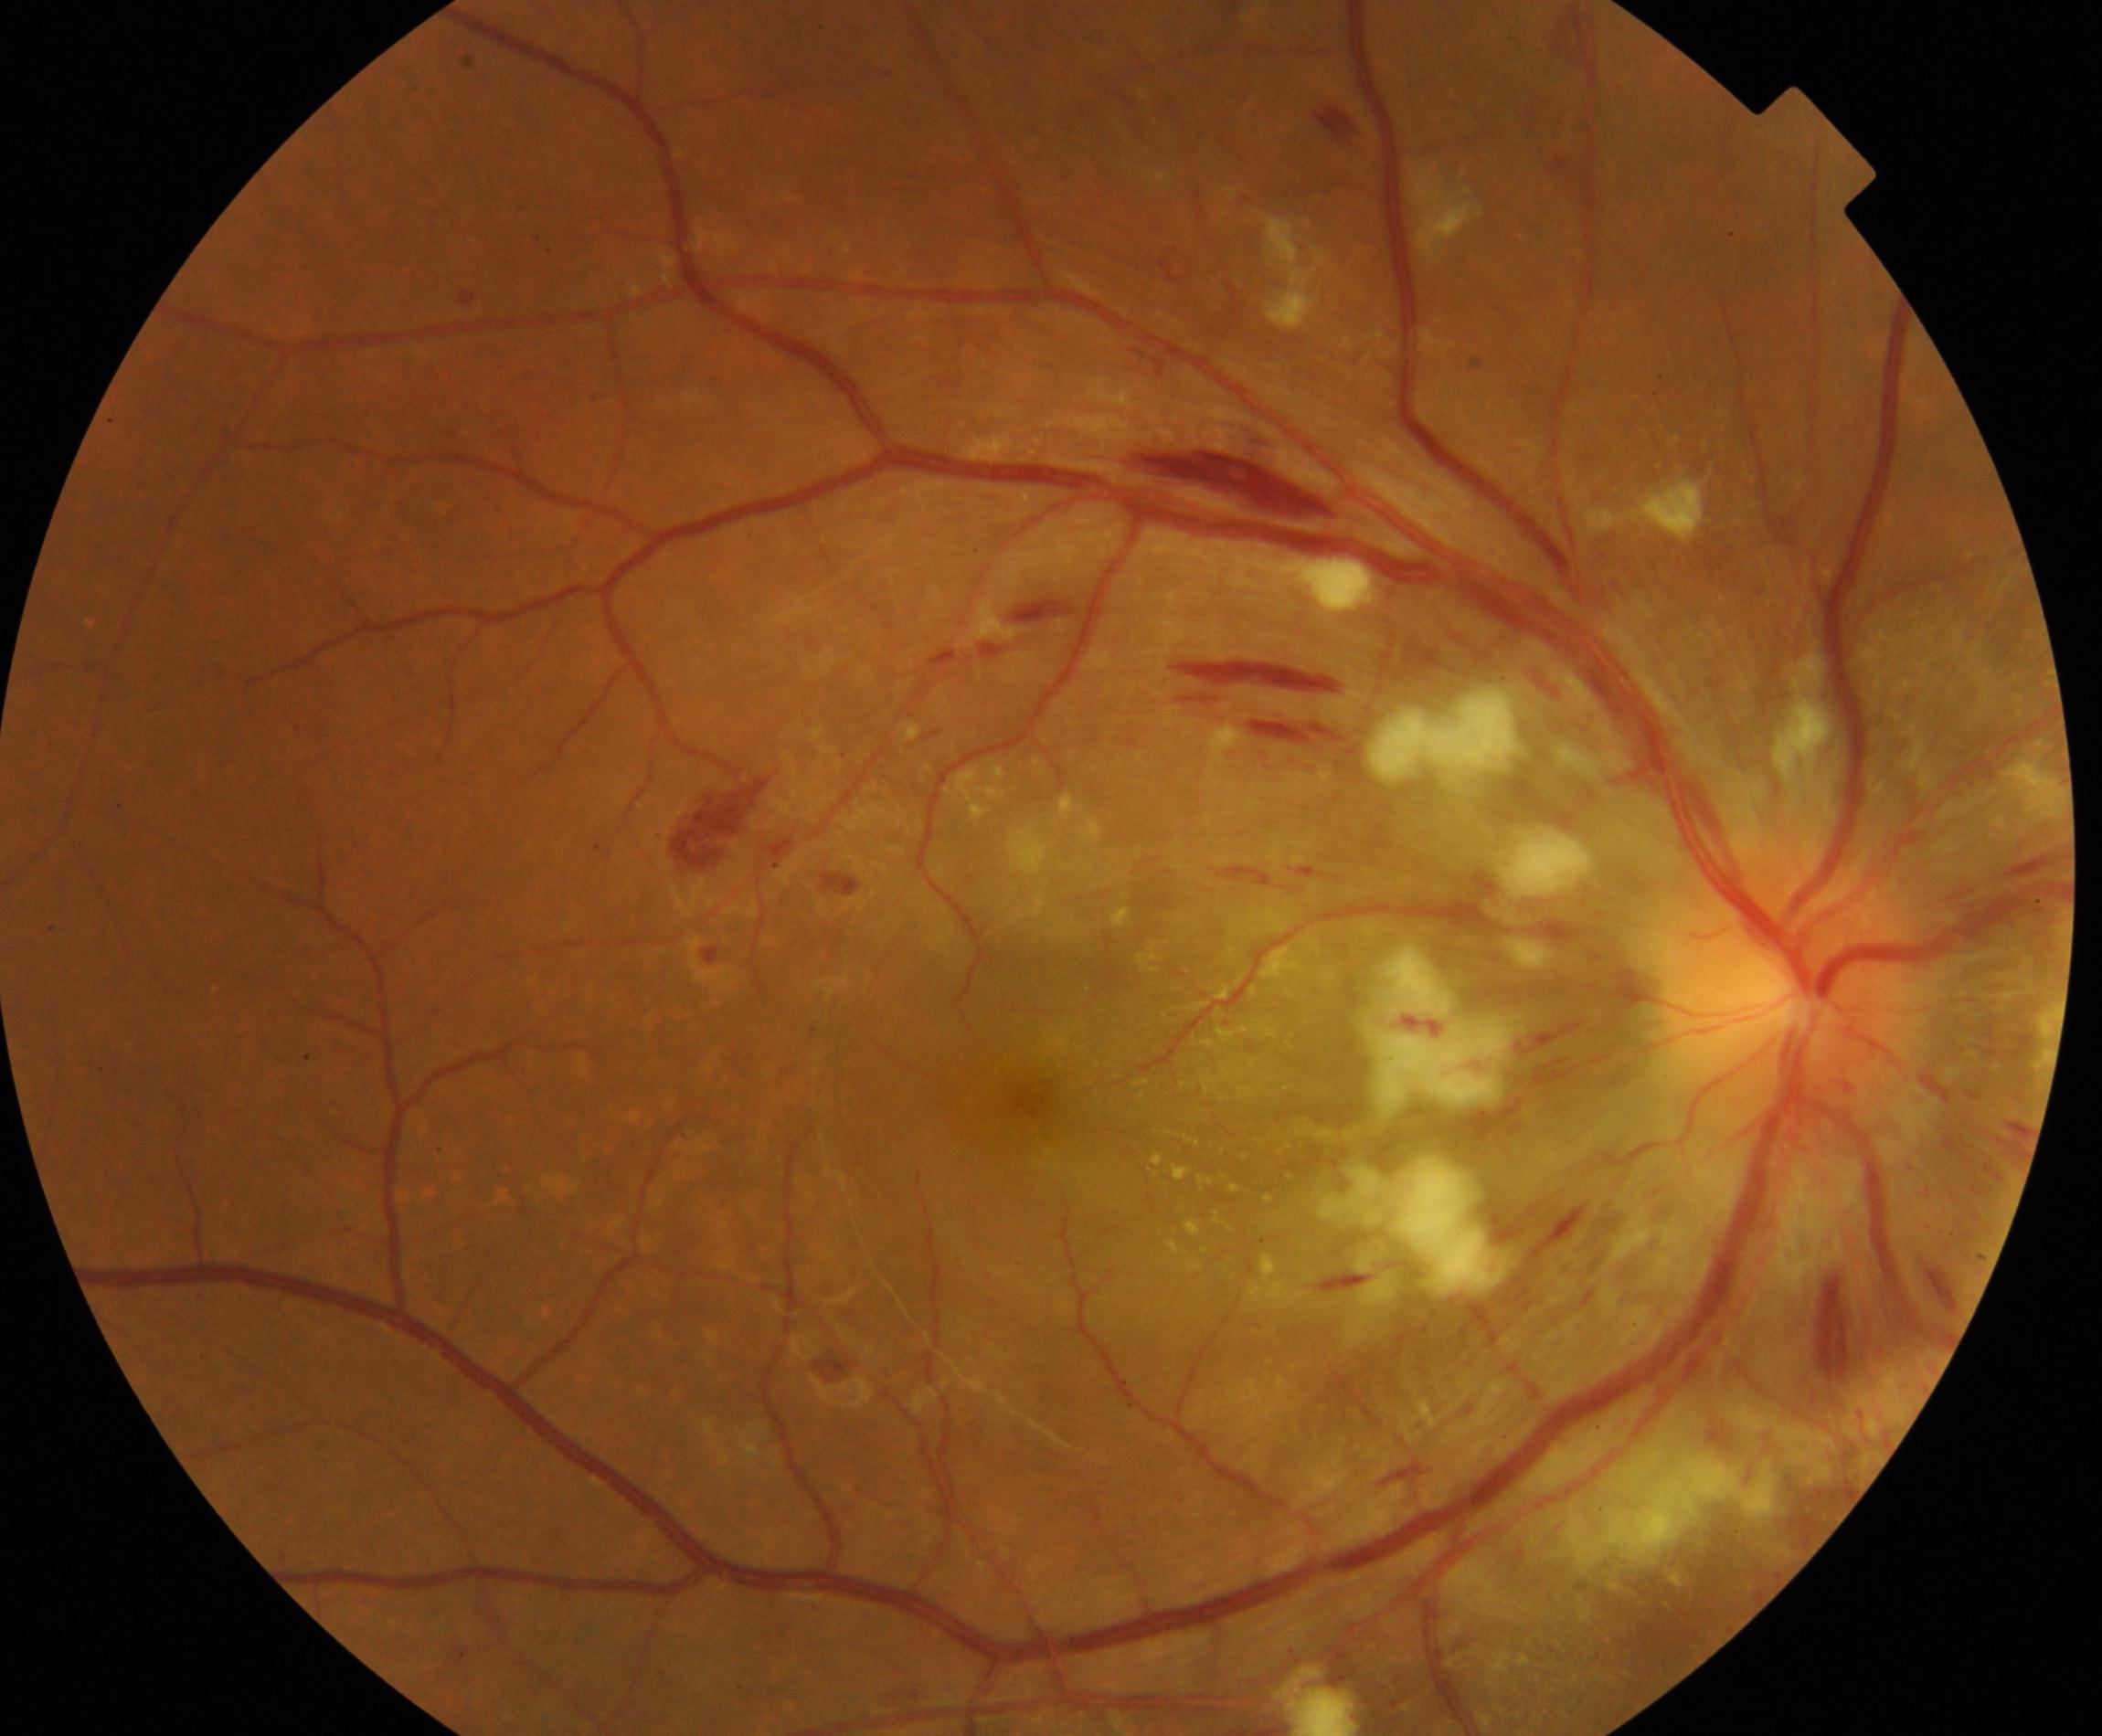
Retinal fundus photograph demonstrating severe hypertensive retinopathy.